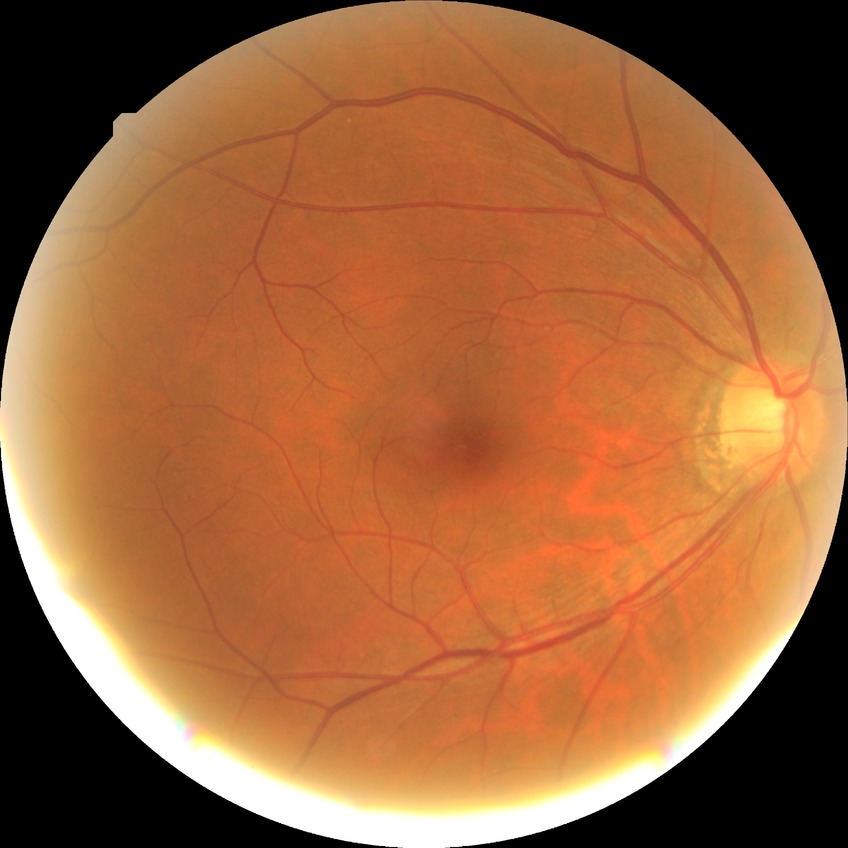 Modified Davis classification is no diabetic retinopathy.